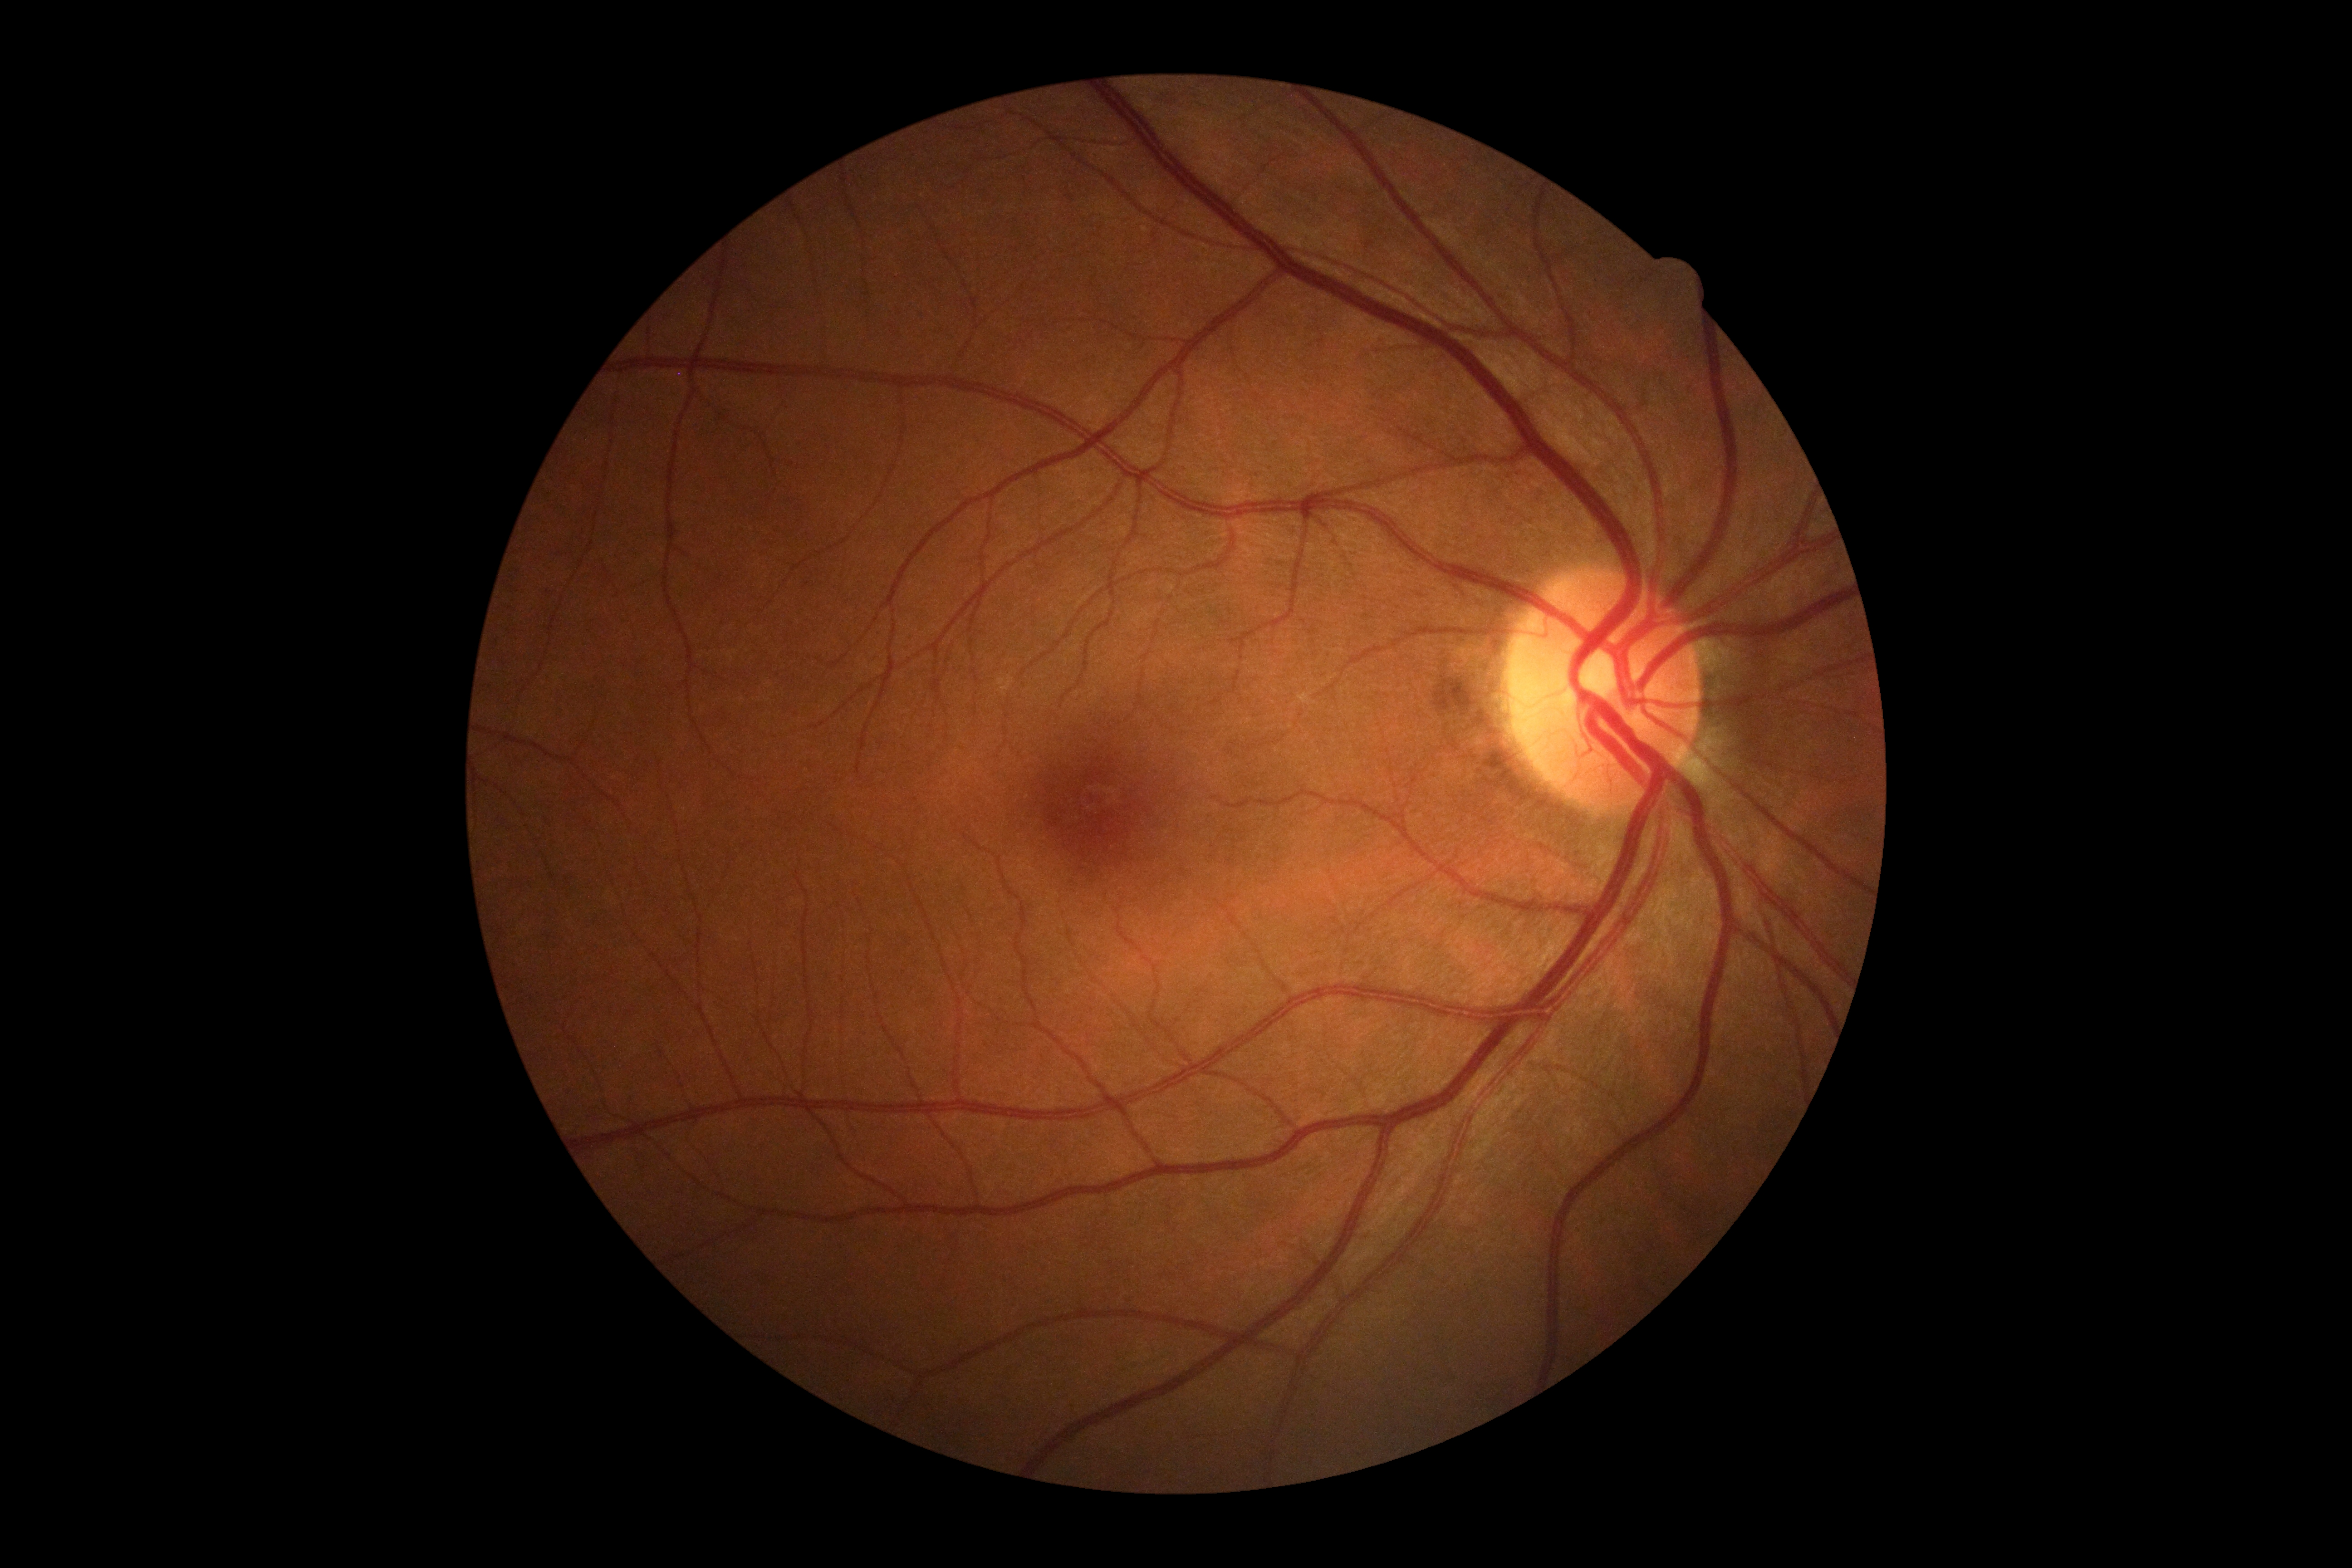

Diabetic retinopathy (DR): grade 0 (no apparent retinopathy).